Image size 1932x1916: 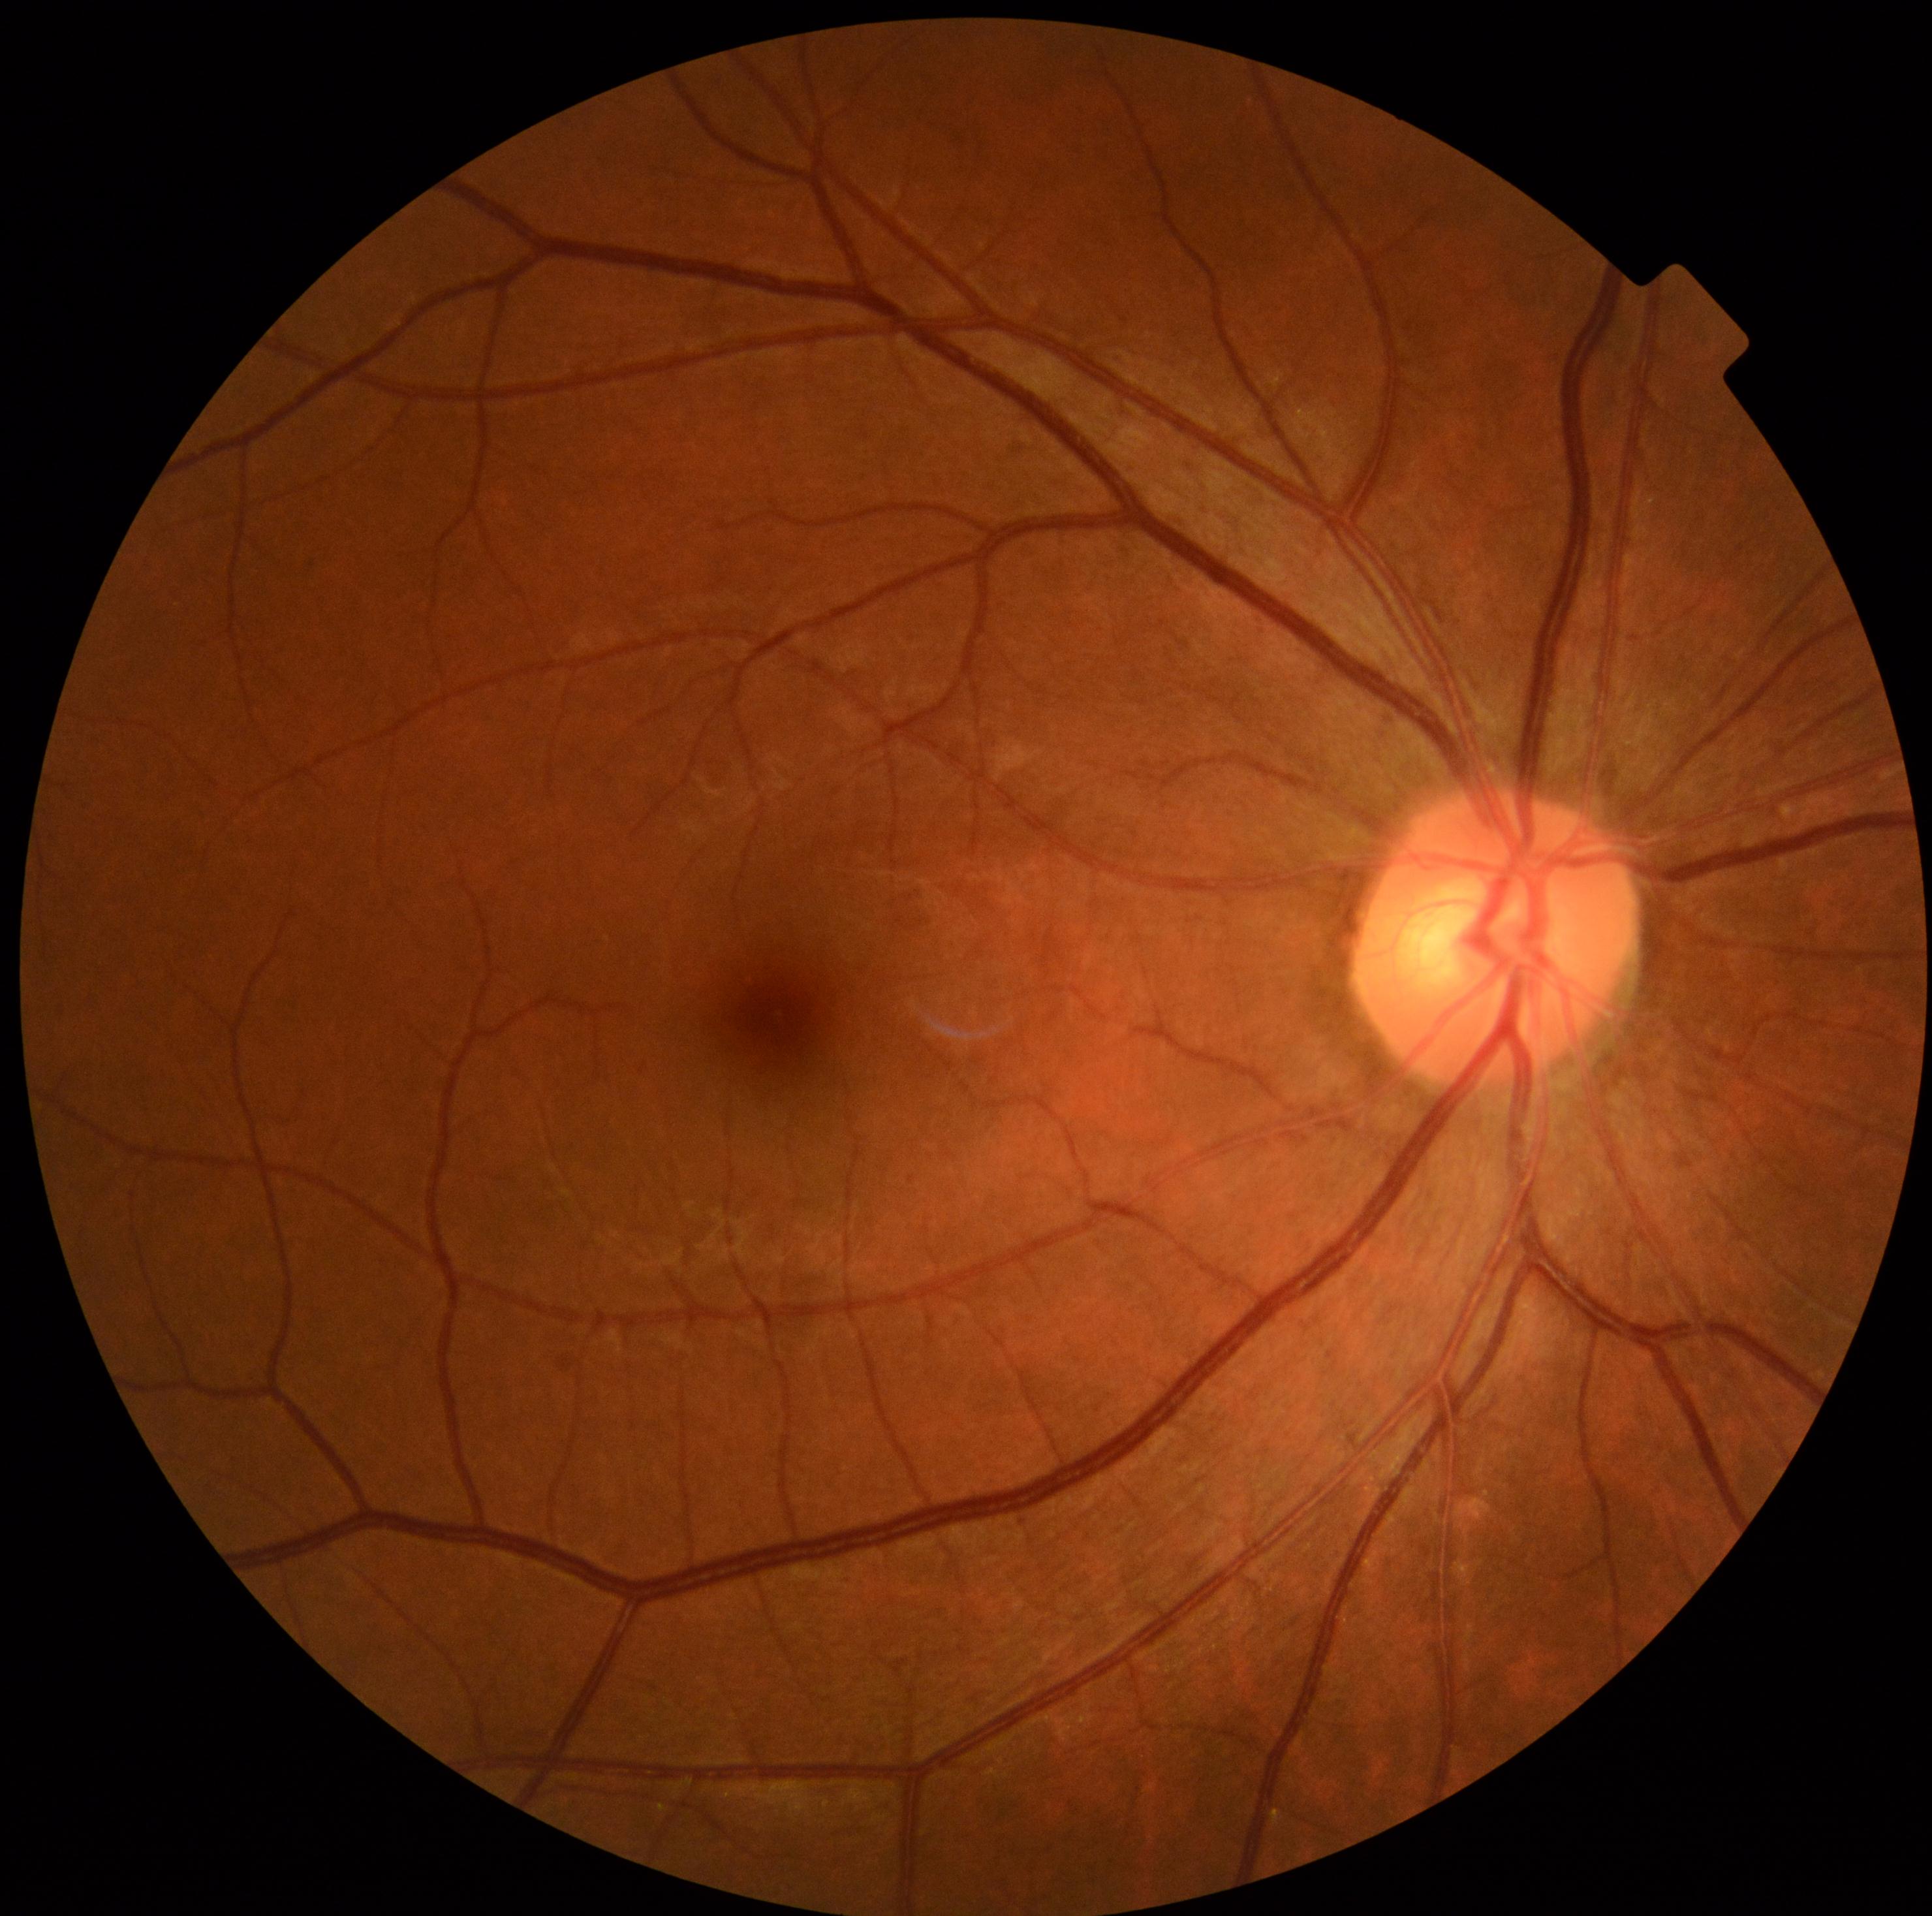 Findings:
– DR class — non-proliferative diabetic retinopathy
– DR stage — 1